Acquired with a NIDEK AFC-230.
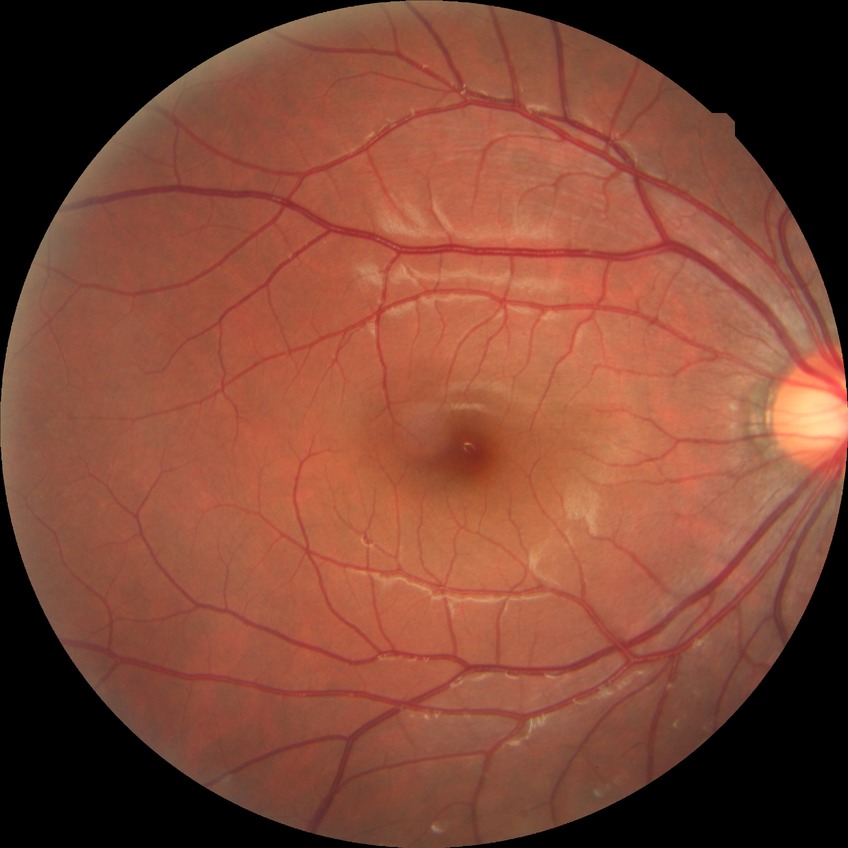
diabetic retinopathy stage@no diabetic retinopathy.